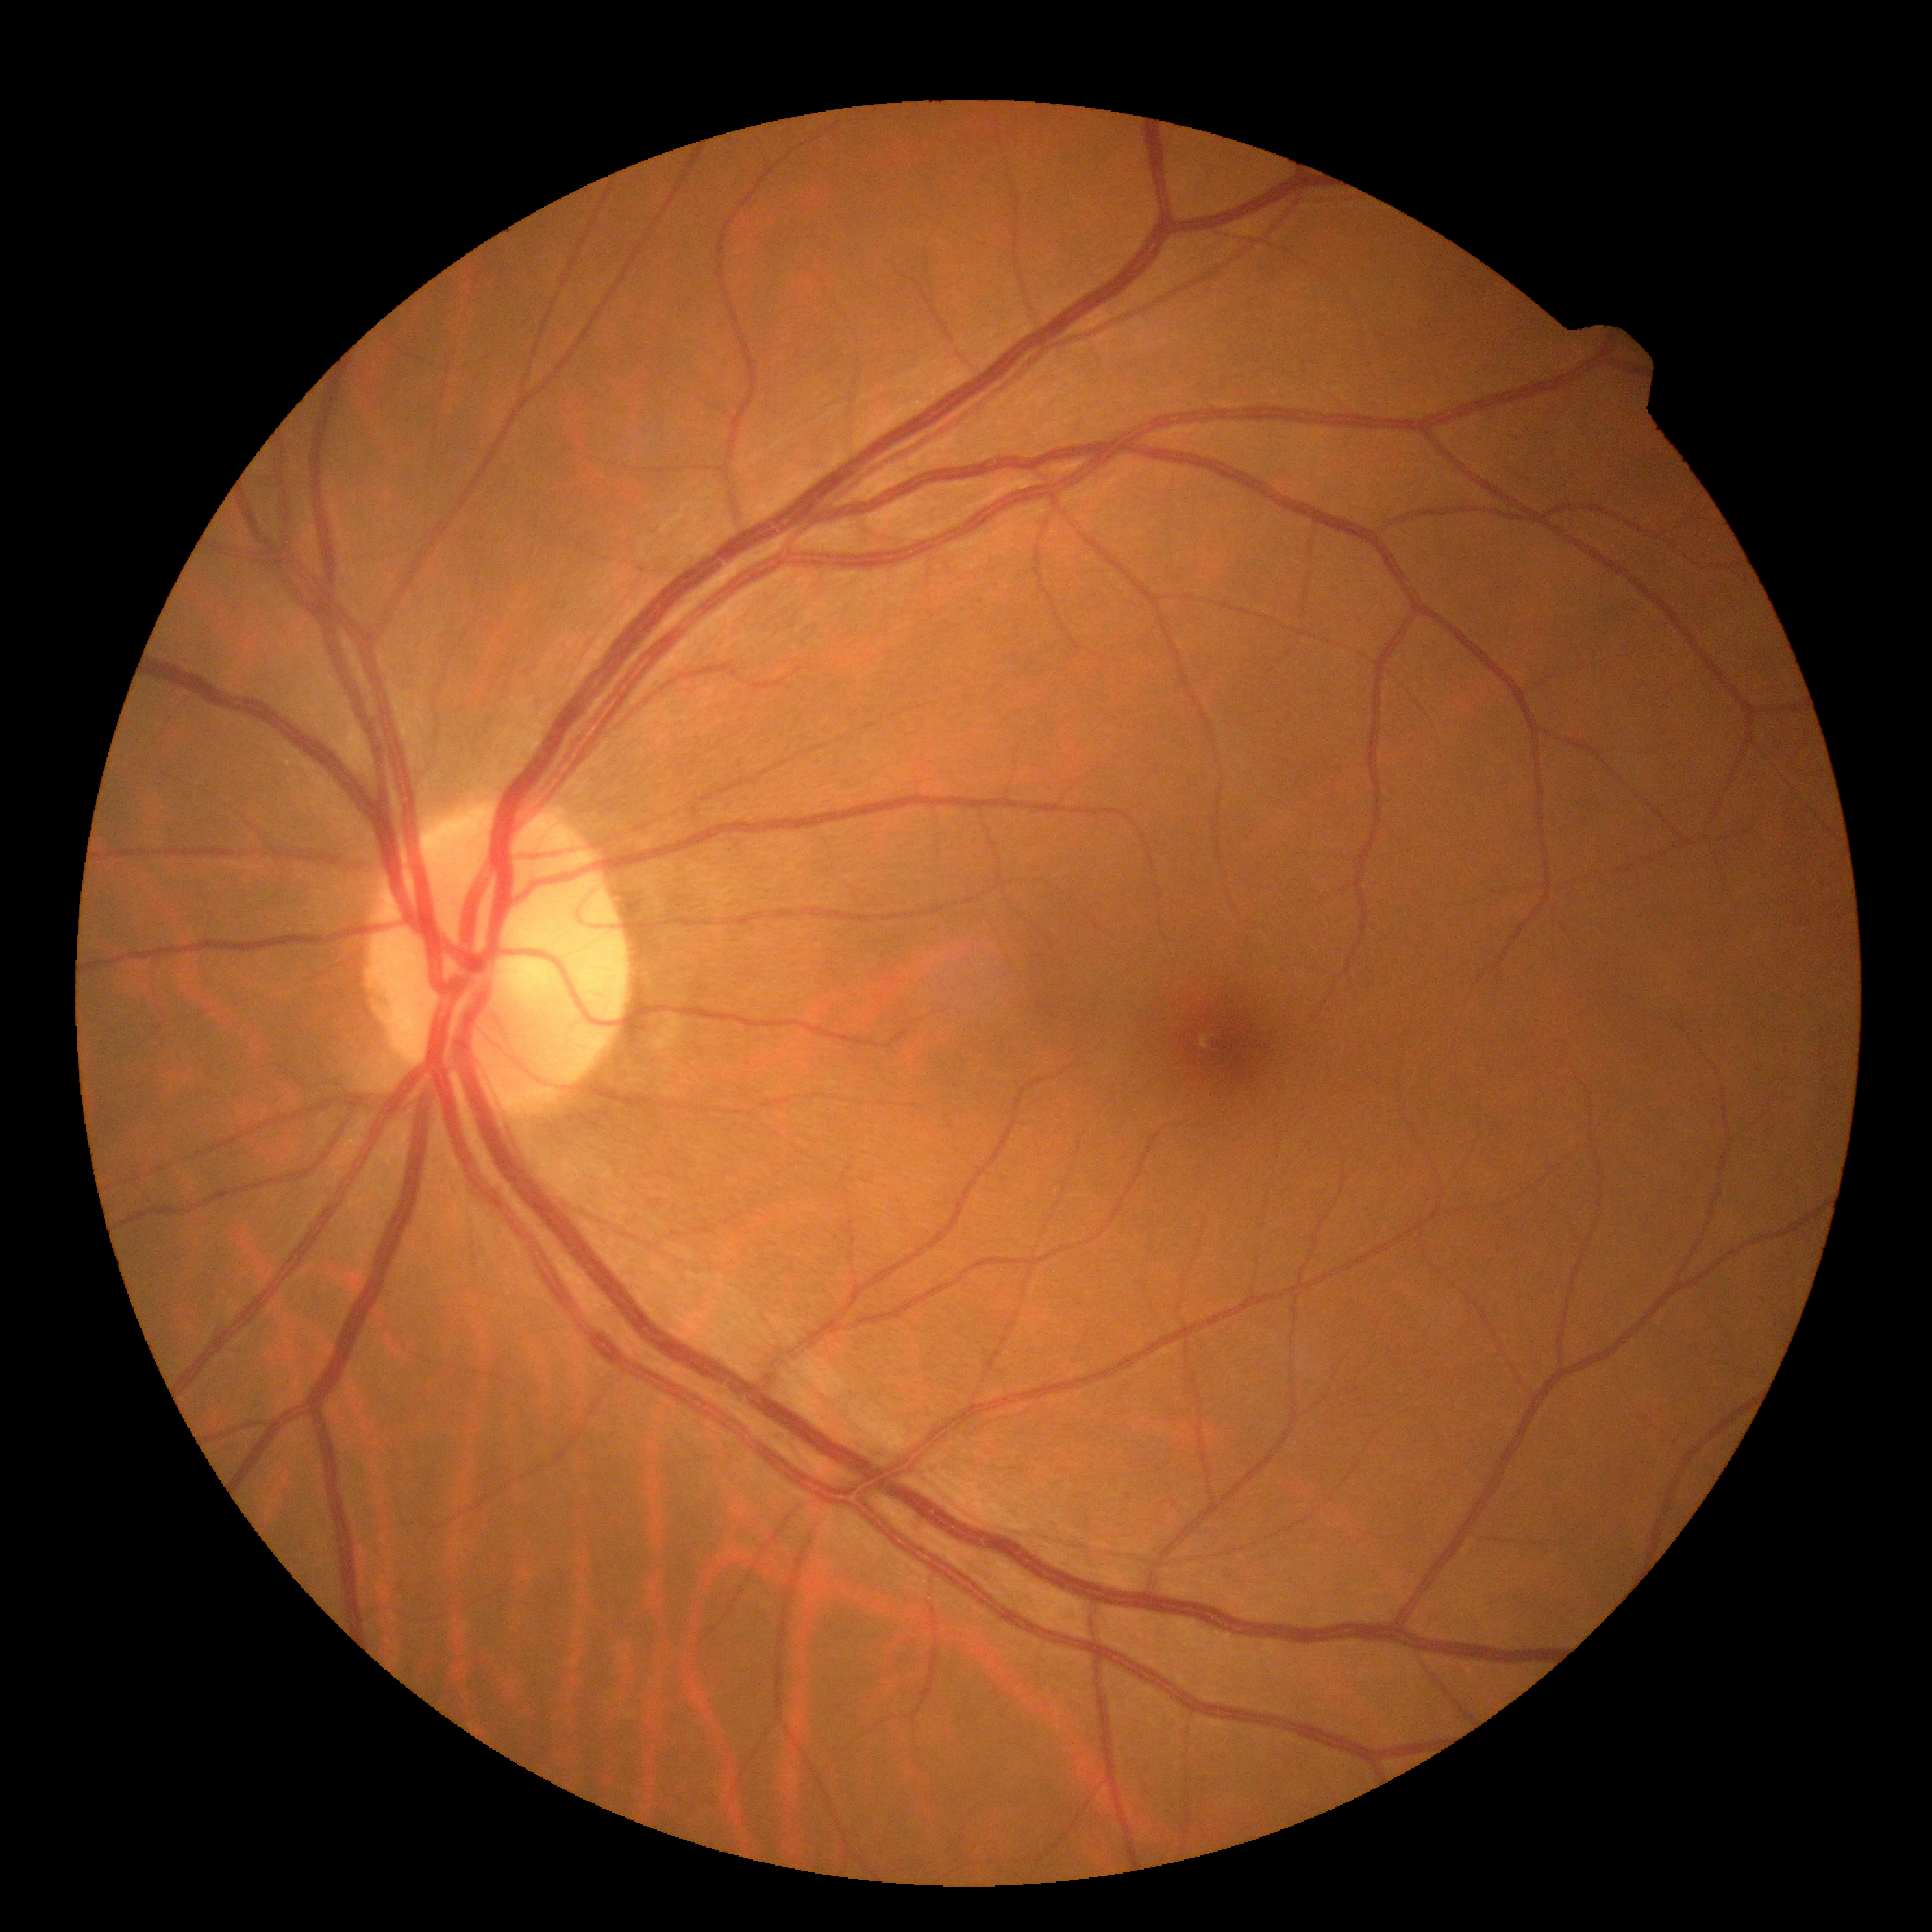 Diabetic retinopathy (DR) is grade 0 (no apparent retinopathy).